1240 x 1240 pixels; Phoenix ICON wide-field infant fundus image.
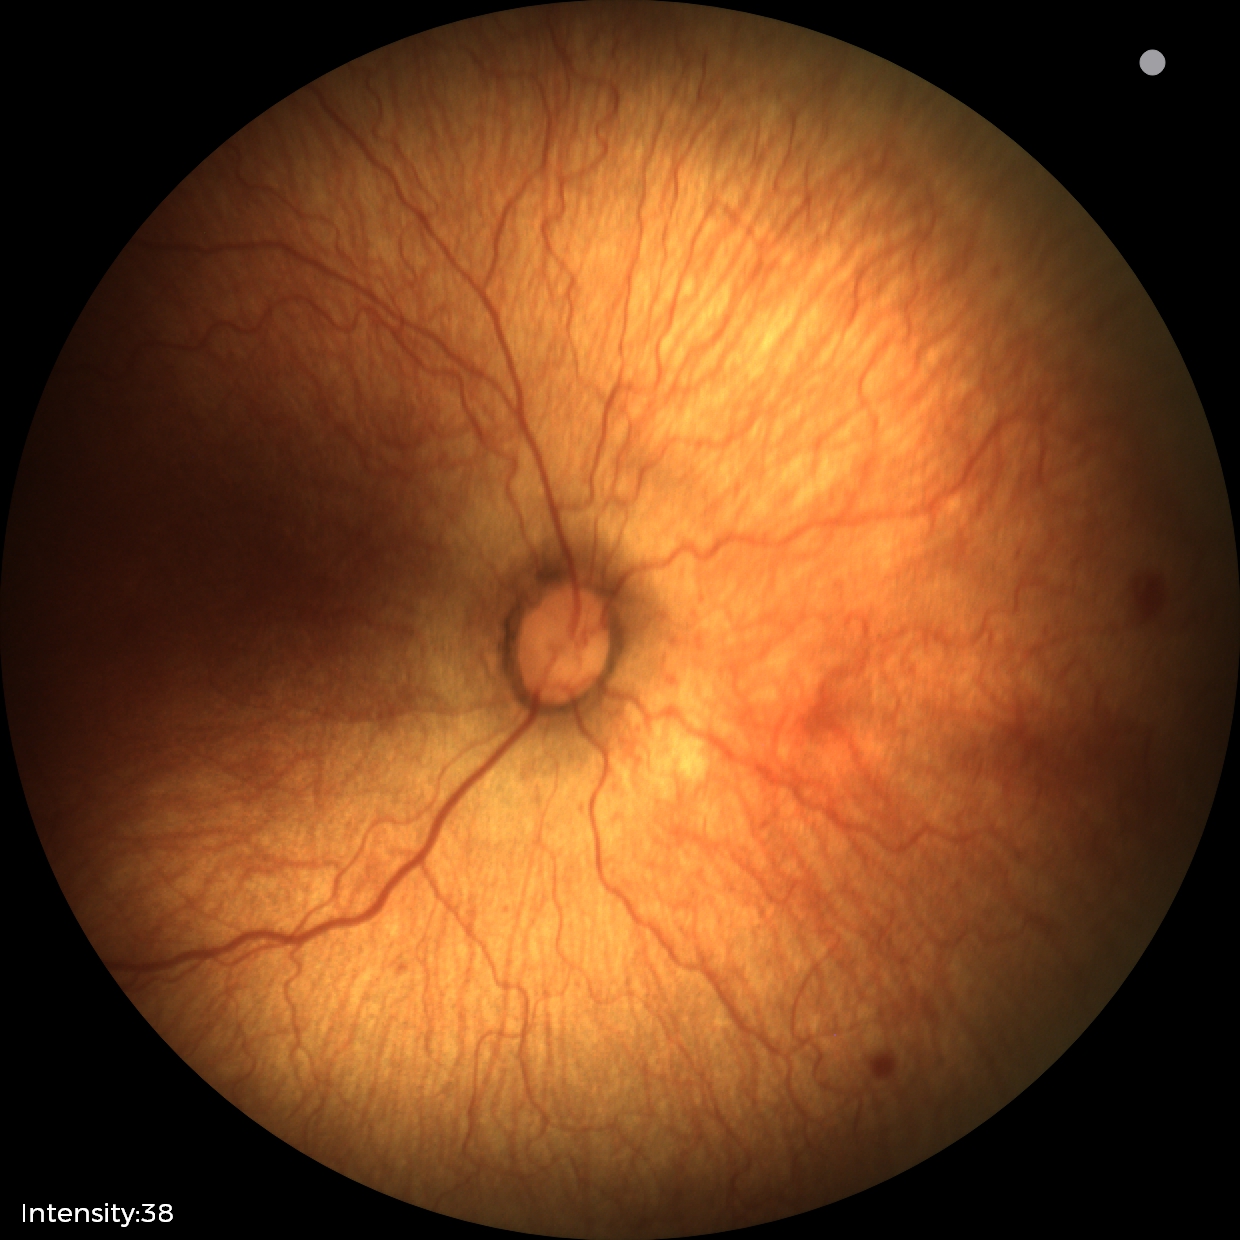
Without plus disease.
Screening examination consistent with retinopathy of prematurity stage 1.